Wide-field contact fundus photograph of an infant: 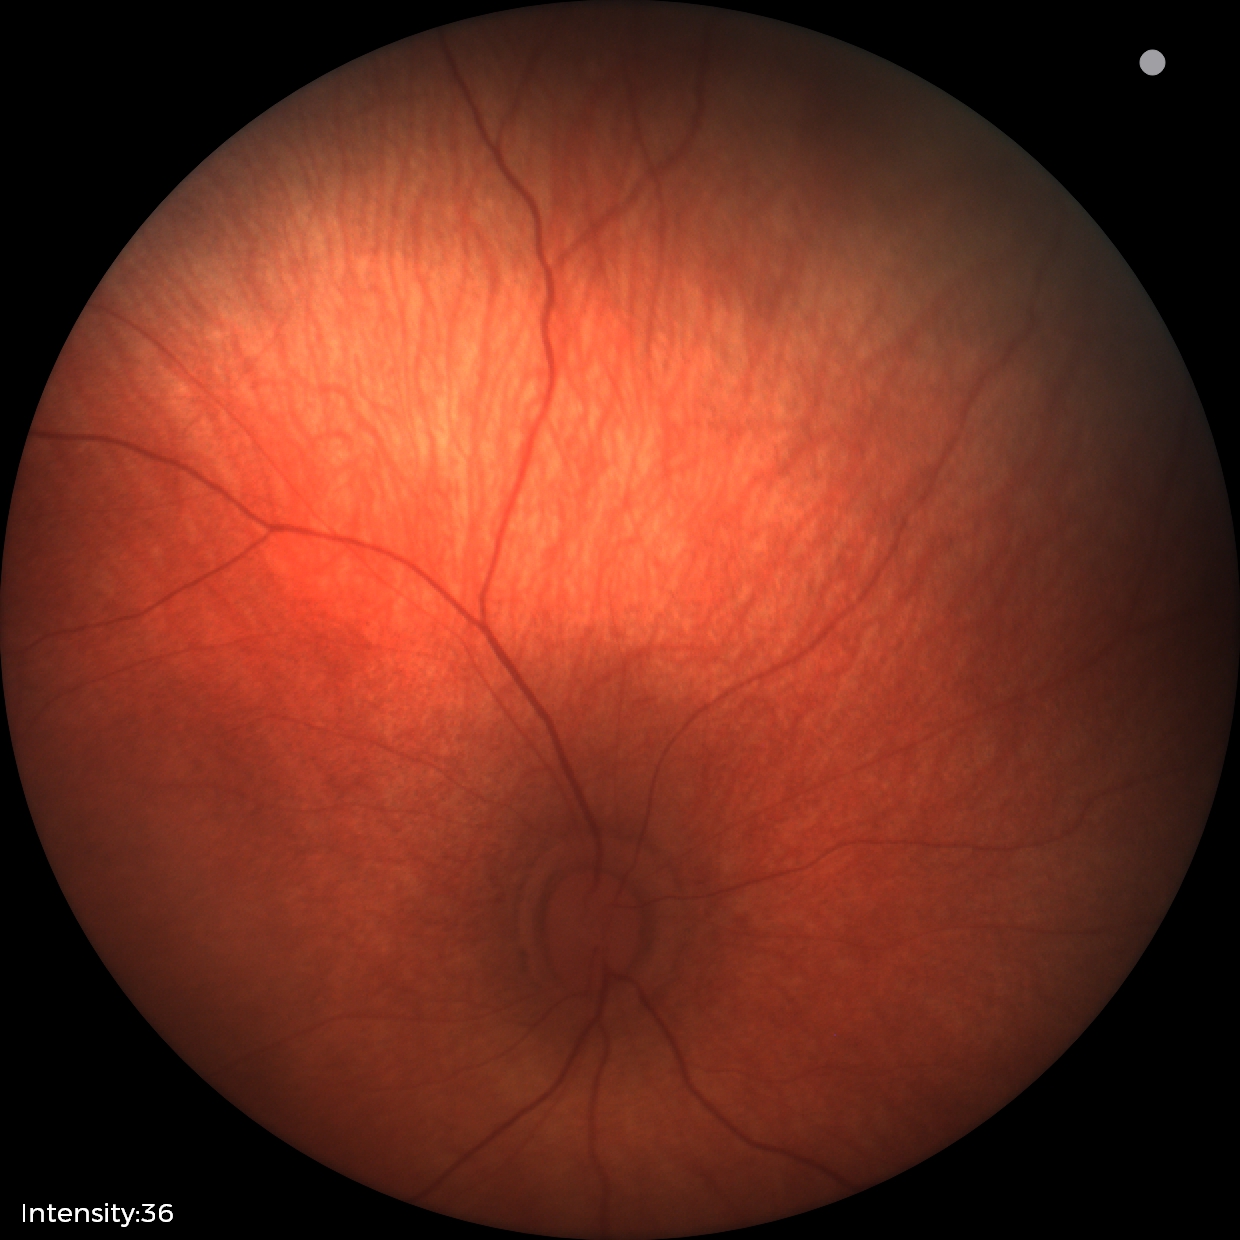
Normal screening examination.